FOV: 50 degrees. 2228 x 1652 pixels: 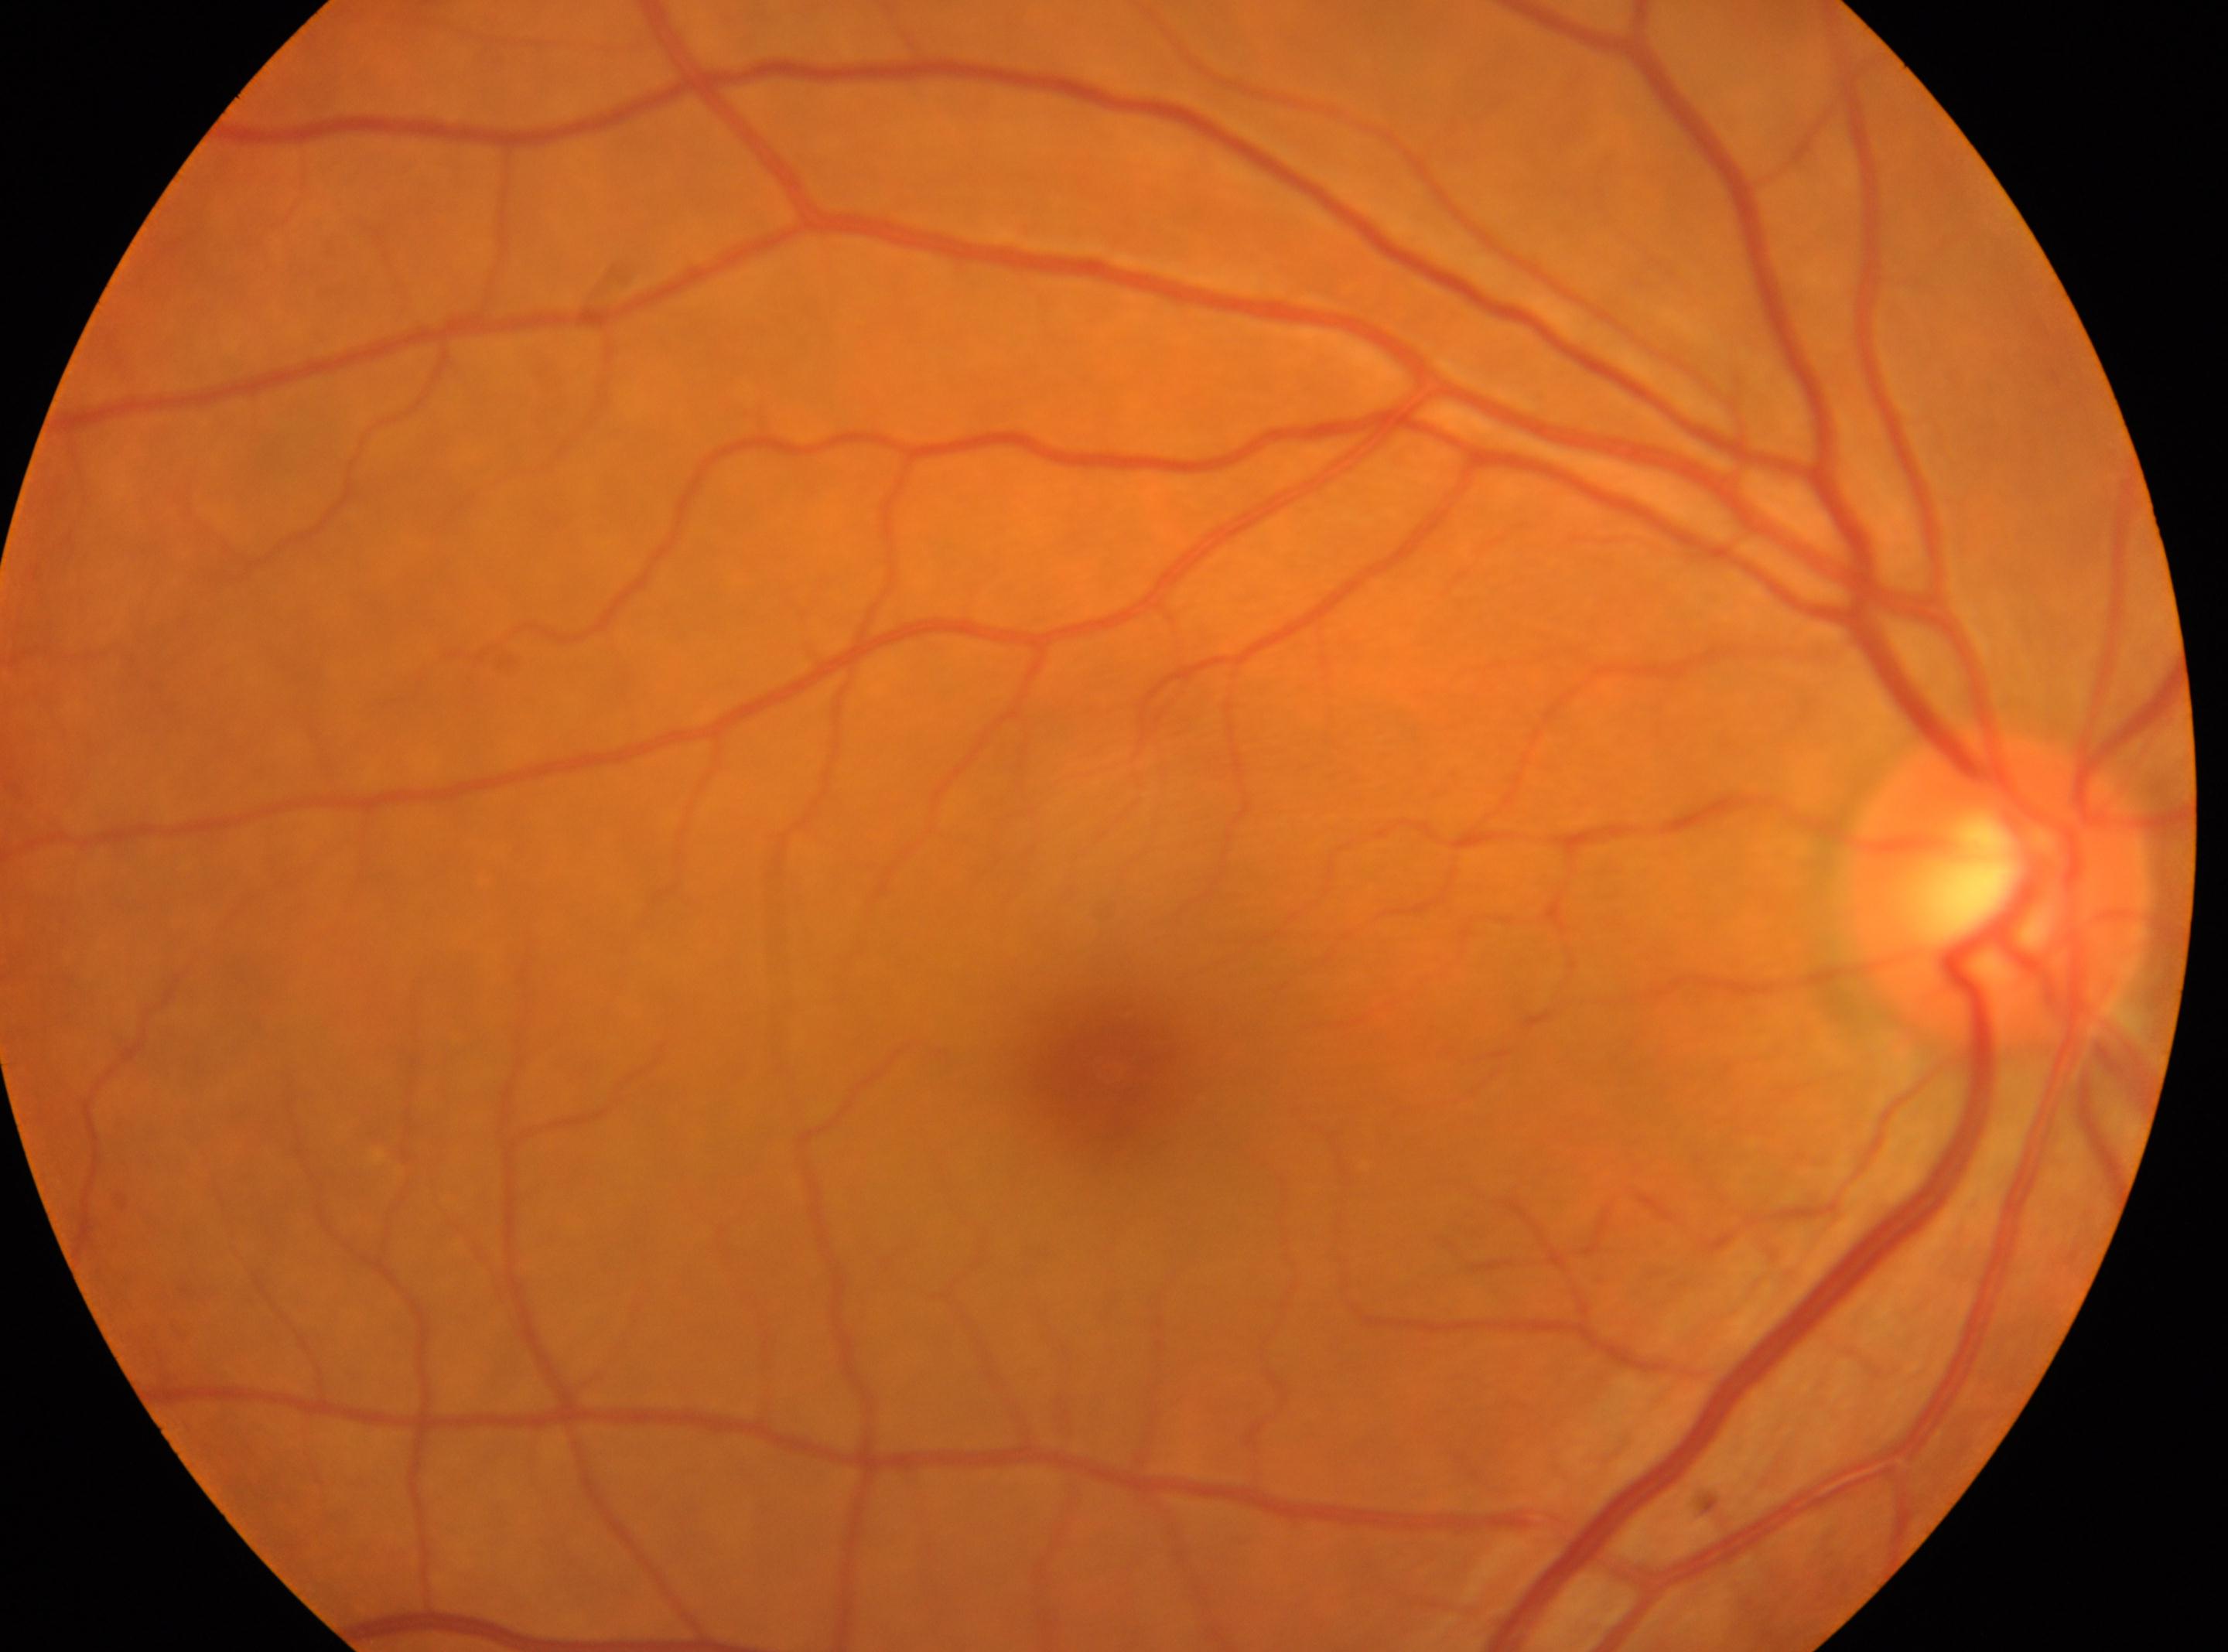
optic_disc: (1997,887)
dr_grade: 0/4
dr_impression: No apparent diabetic retinopathy
eye: the right eye
fovea: (1109,1073)